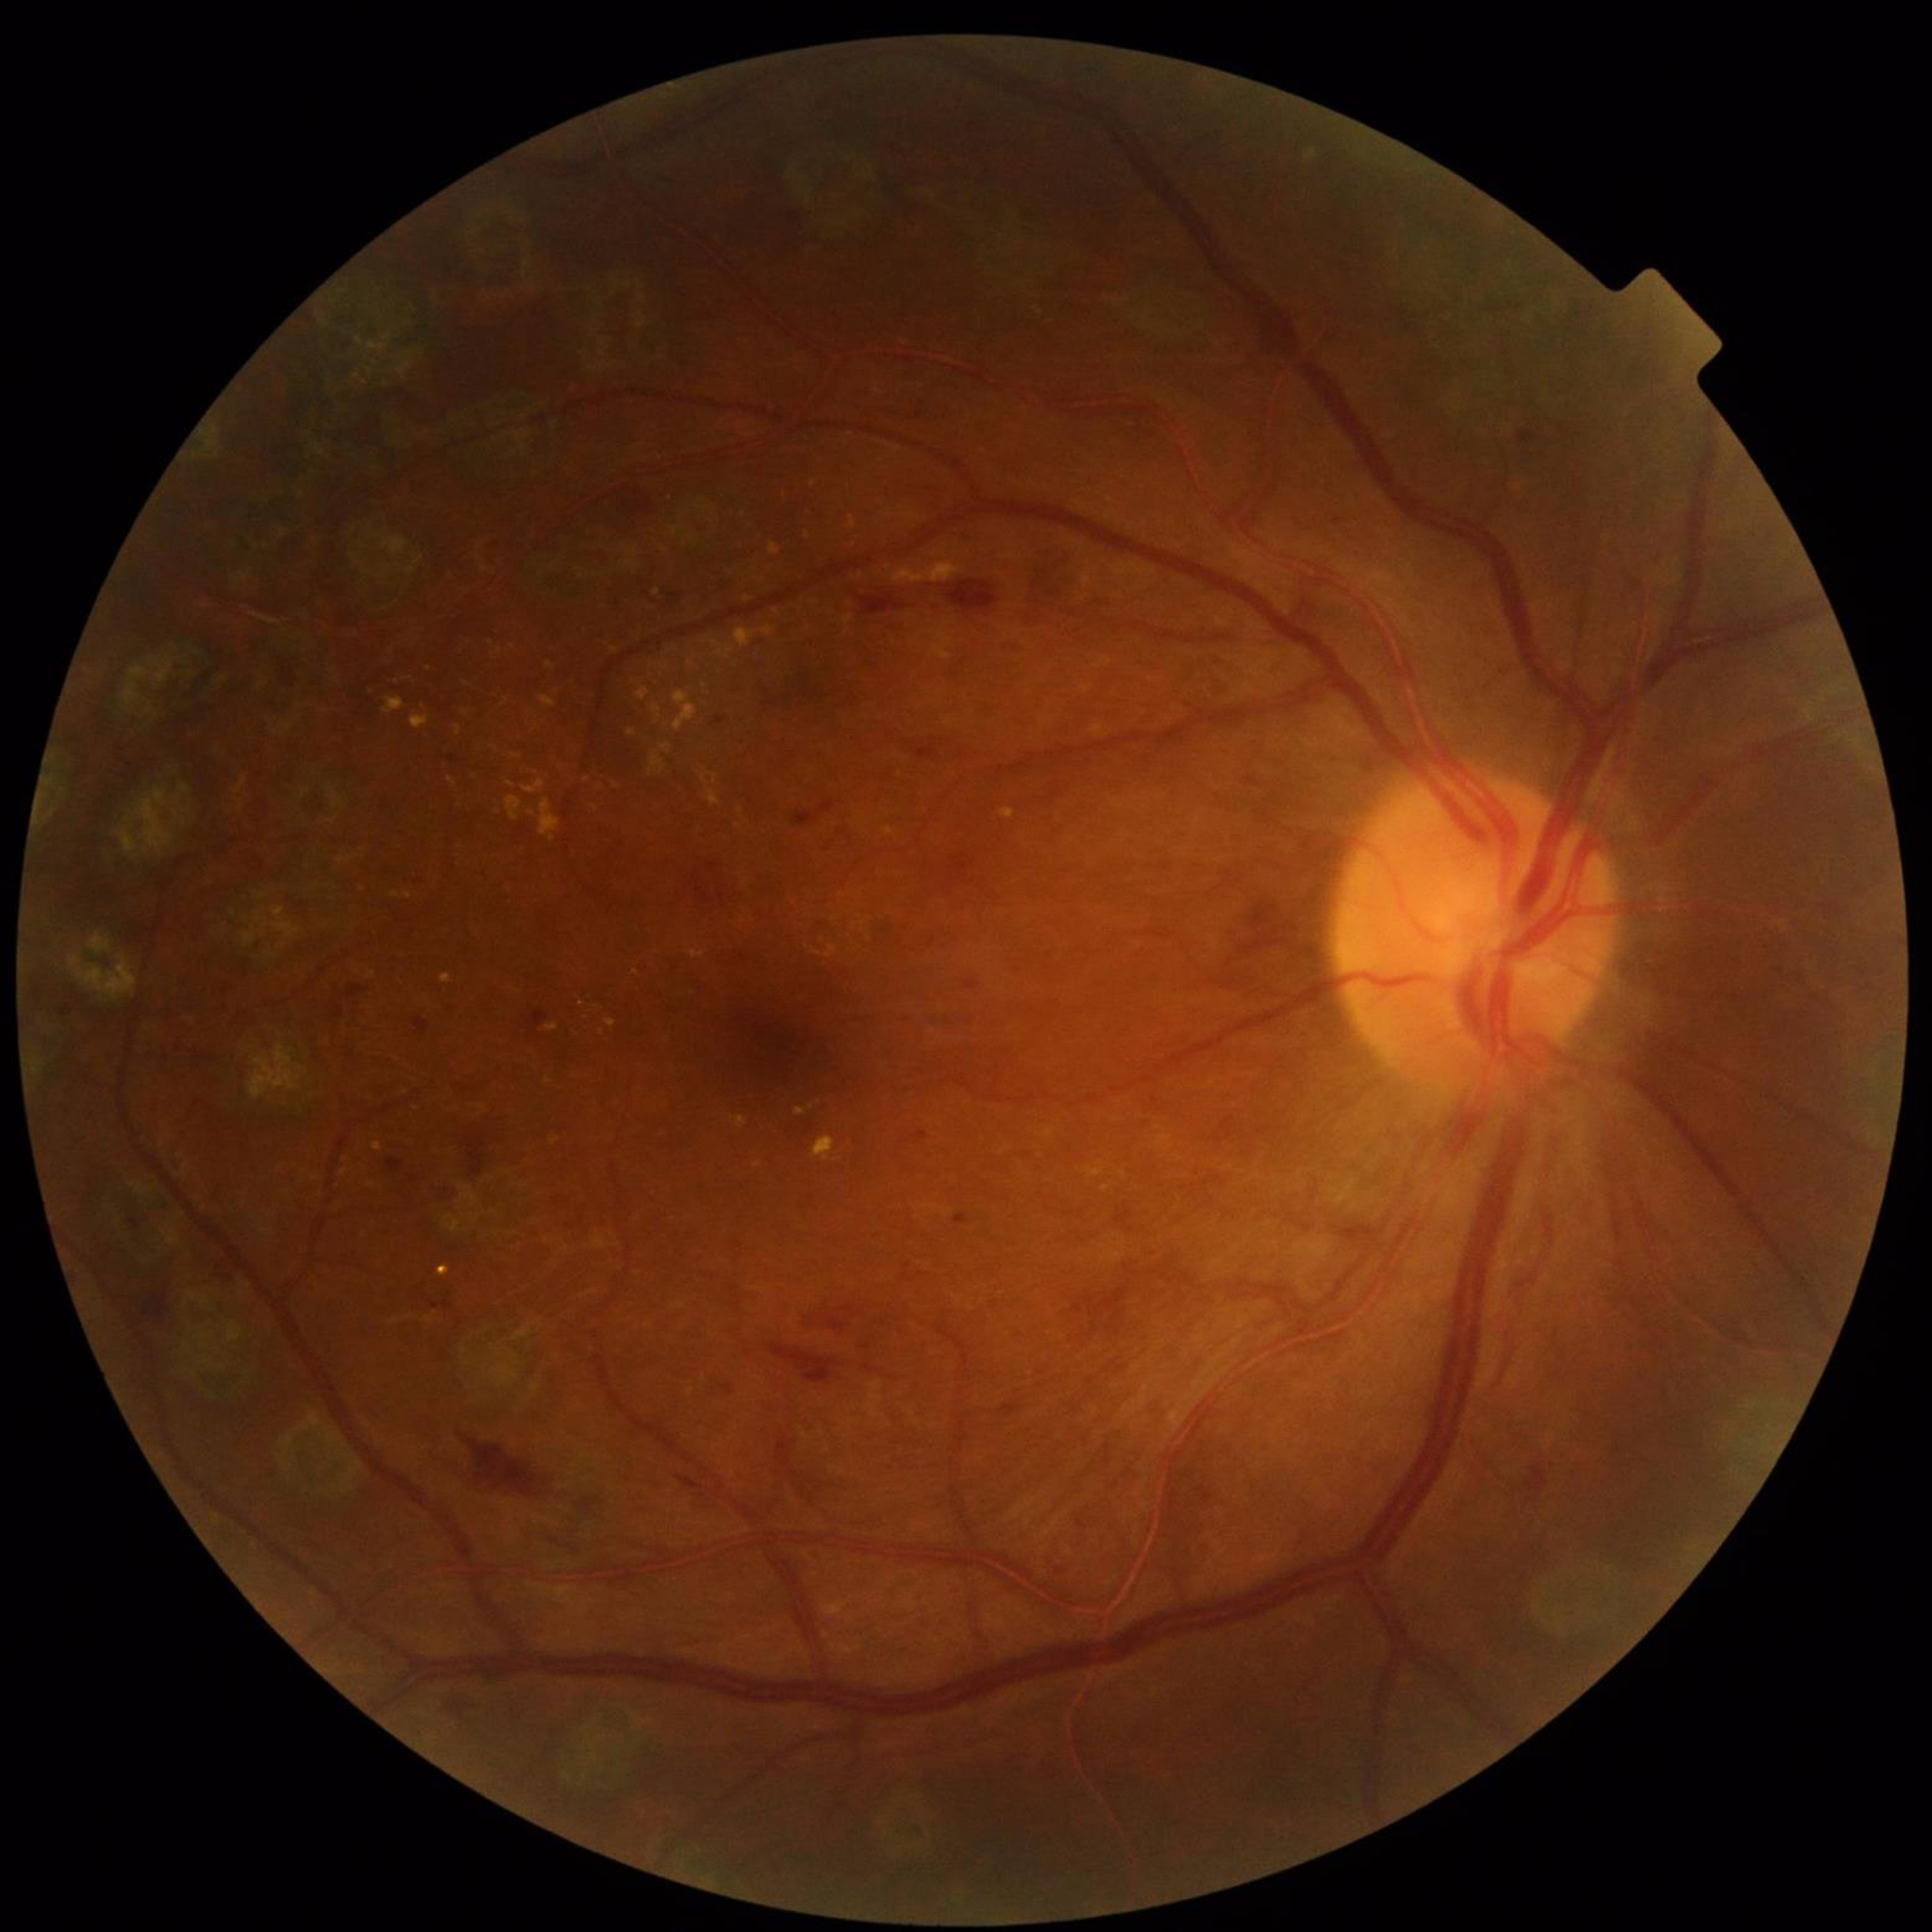

Condition = DR; Photo quality = satisfactory.